DR severity per modified Davis staging · retinal fundus photograph — 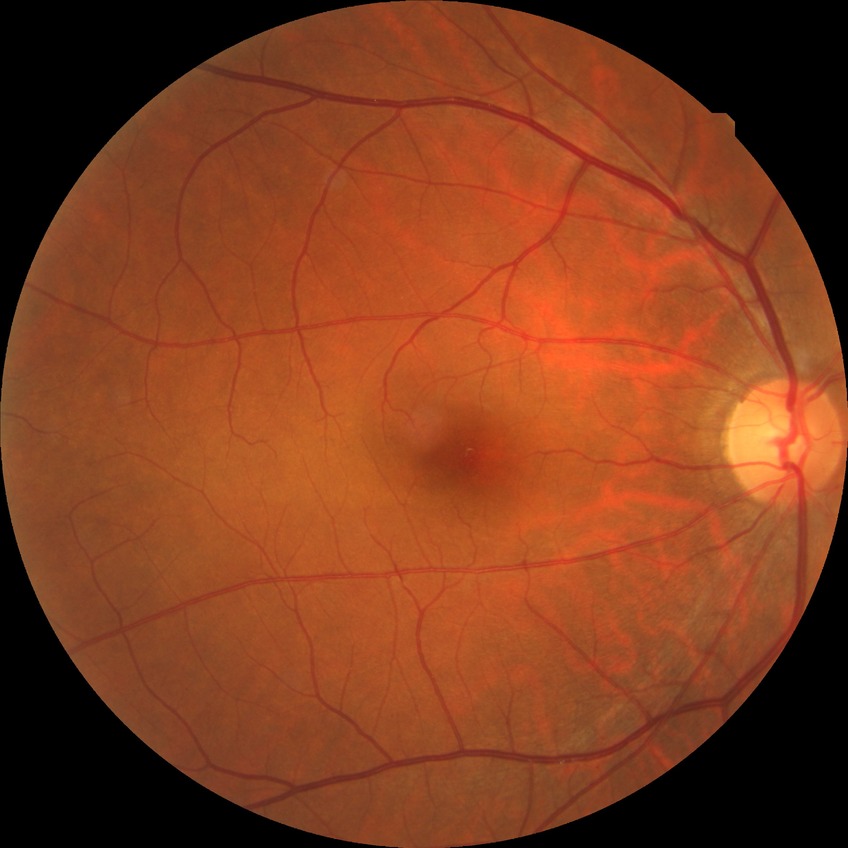 DR grade is NDR.